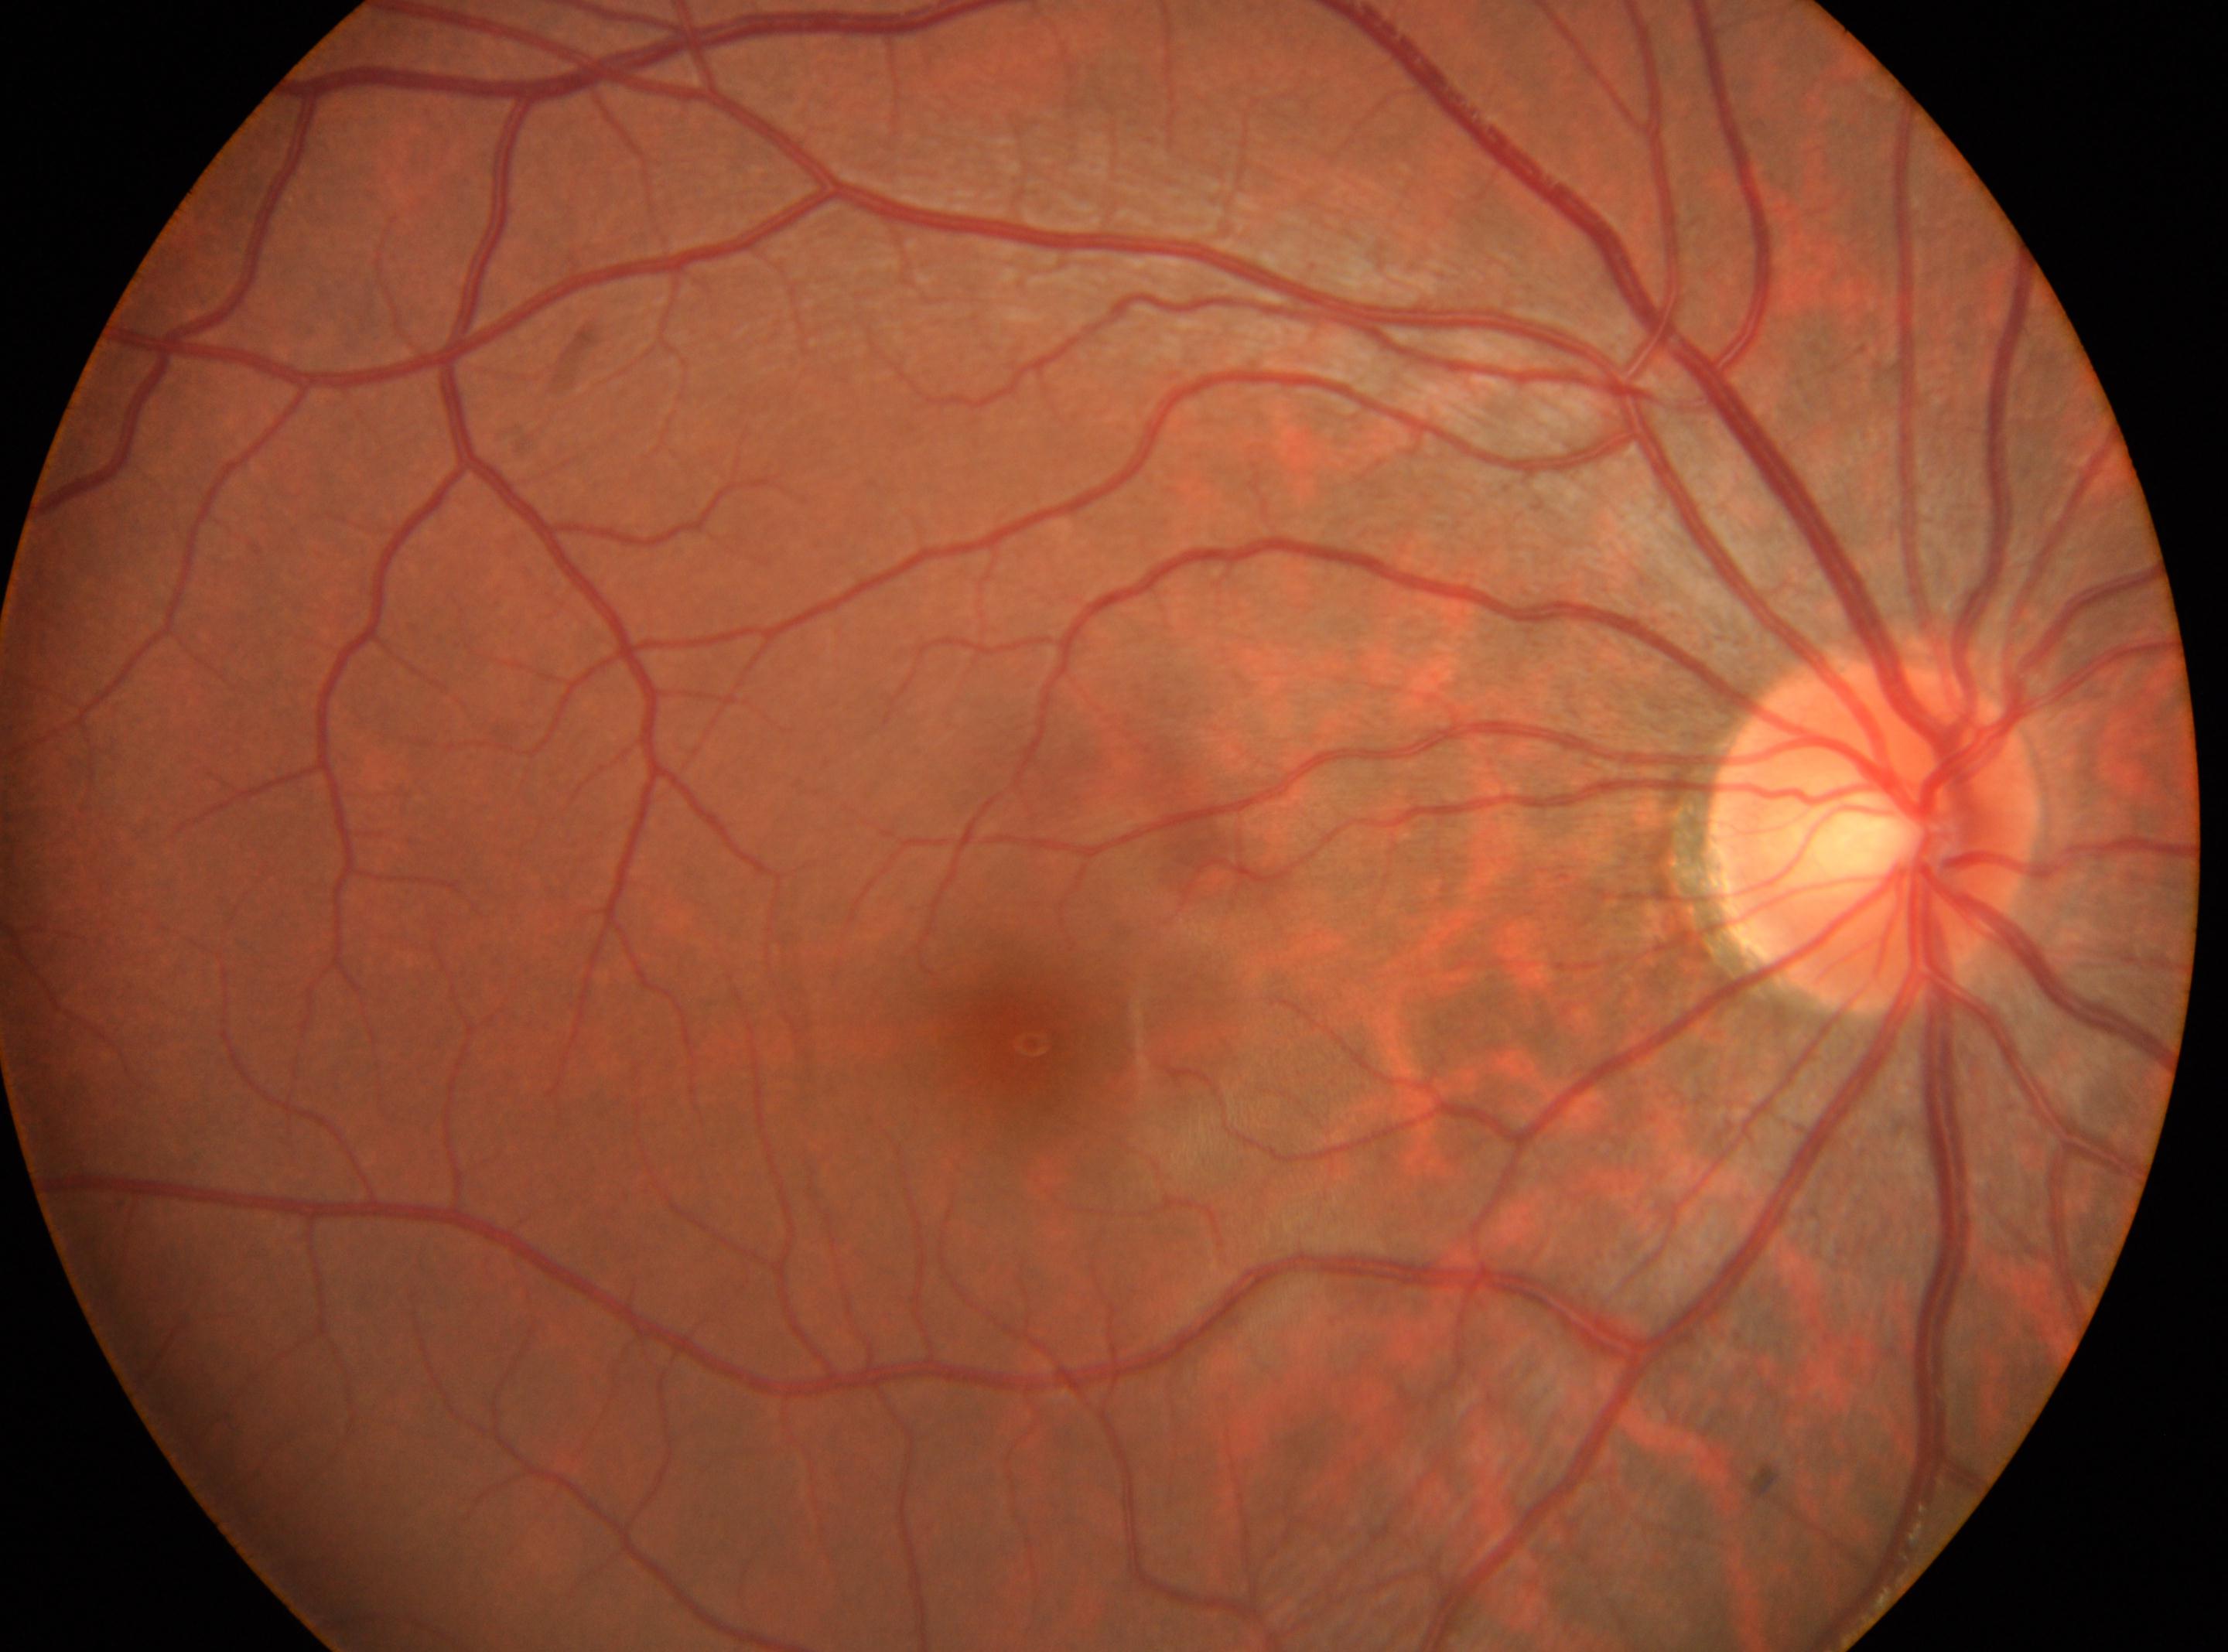

DR grade: no apparent retinopathy (0).
The fovea centralis is at (x=1021, y=1036).
Optic disc center: (x=1874, y=833).
Imaged eye: OD.